CFP; disc-centered field; 240x240px:
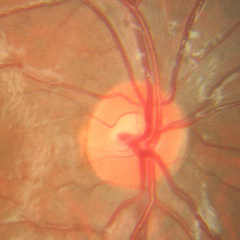
No signs of glaucoma.